Color fundus photograph, 2048x1536: 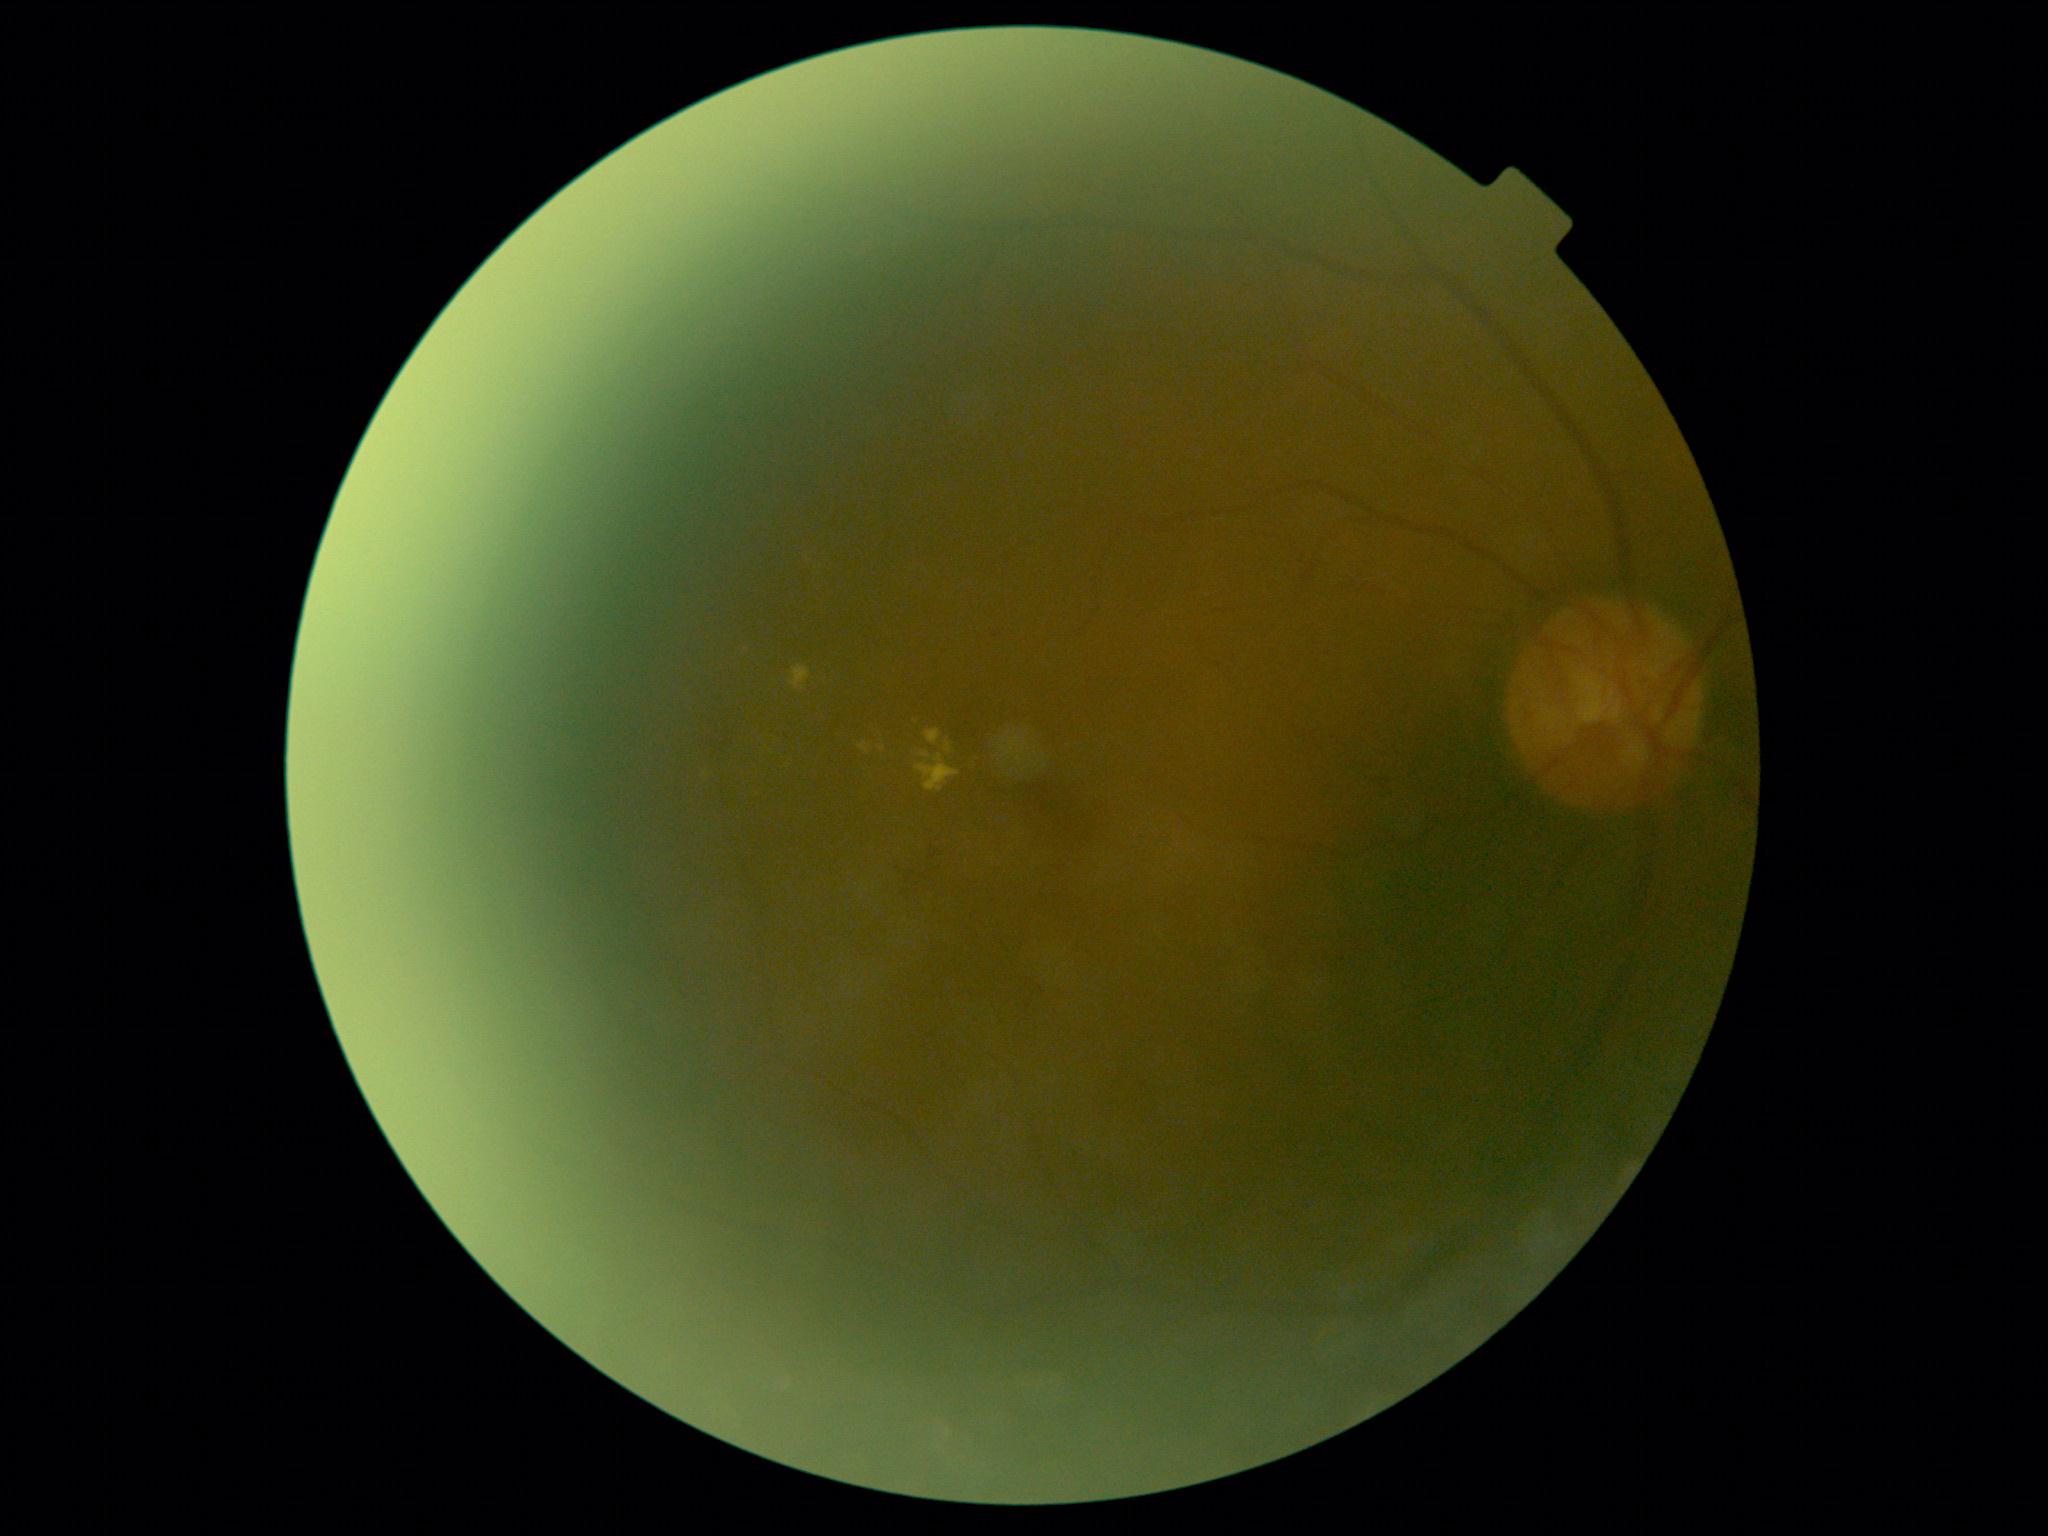 DR class: non-proliferative diabetic retinopathy. DR severity is grade 2 (moderate NPDR) — more than just microaneurysms but less than severe NPDR.